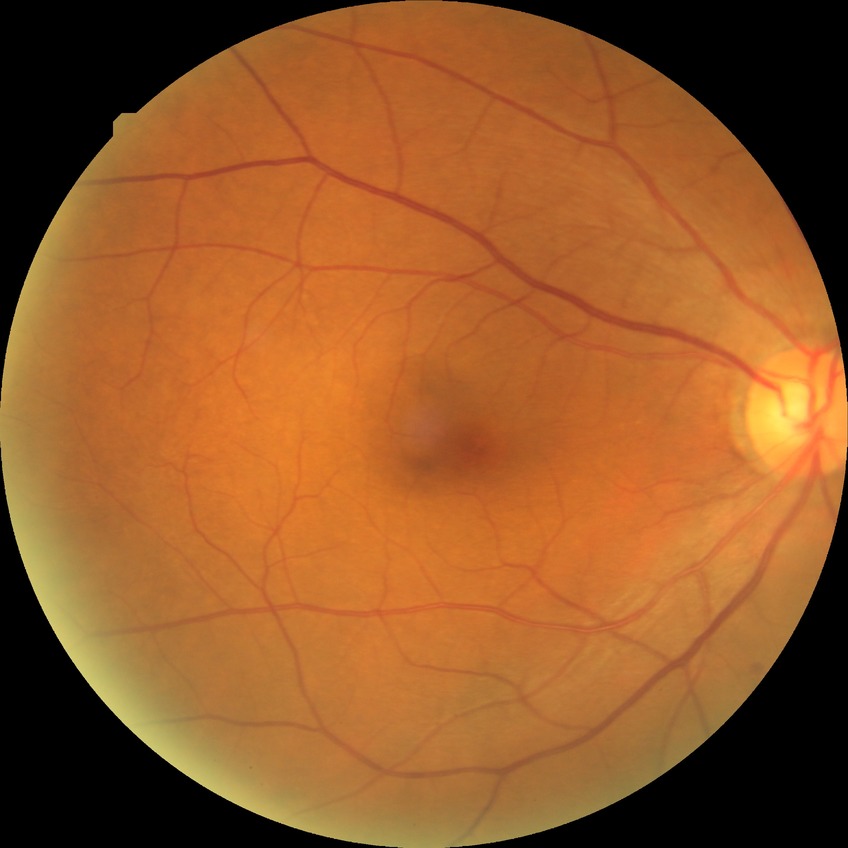
Diabetic retinopathy (DR) is NDR (no diabetic retinopathy).